CFP: 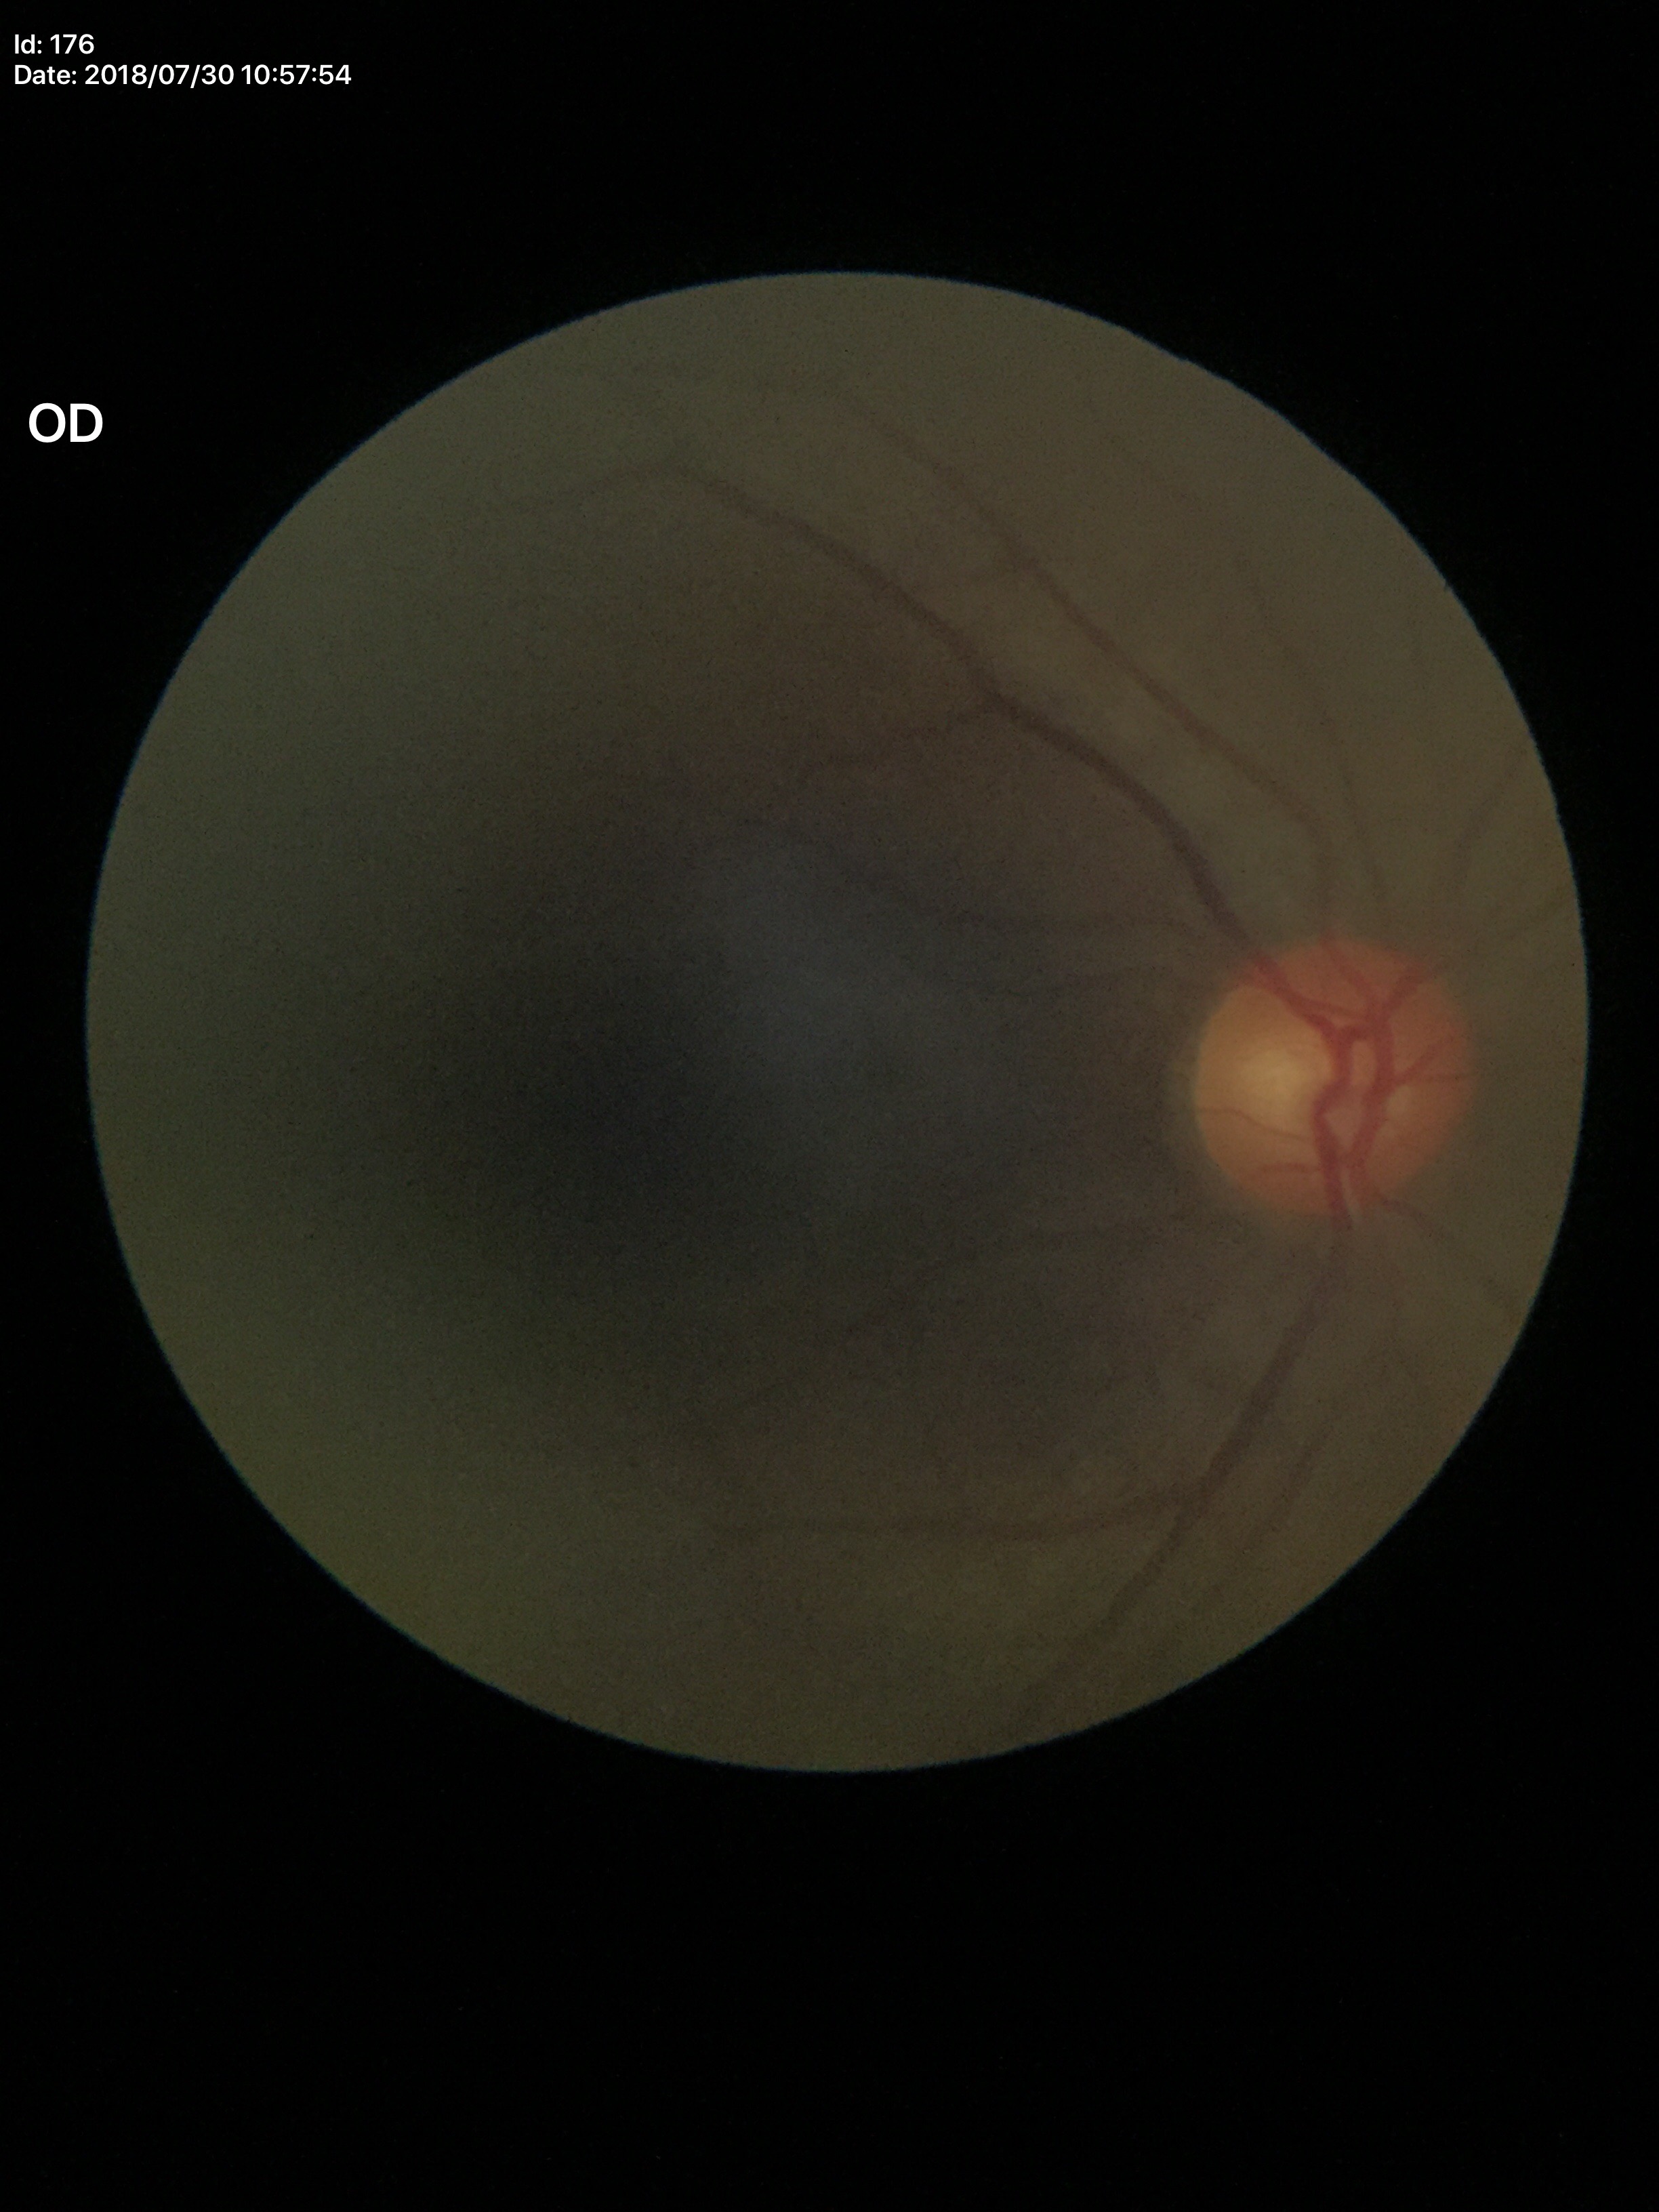
Glaucoma evaluation: not suspect (two of five ophthalmologists flagged glaucoma suspect) | vertical cup-disc ratio (VCDR): 0.57 | area C/D ratio (ACDR): 0.34